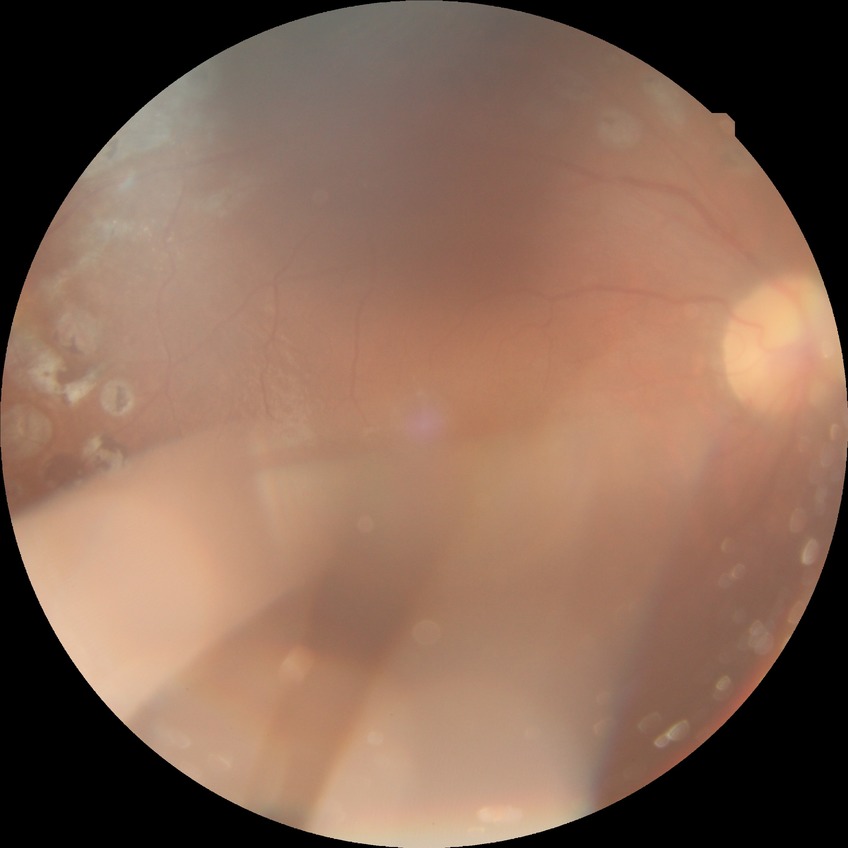

Davis stage: PDR.